Portable fundus photograph. 60° field of view:
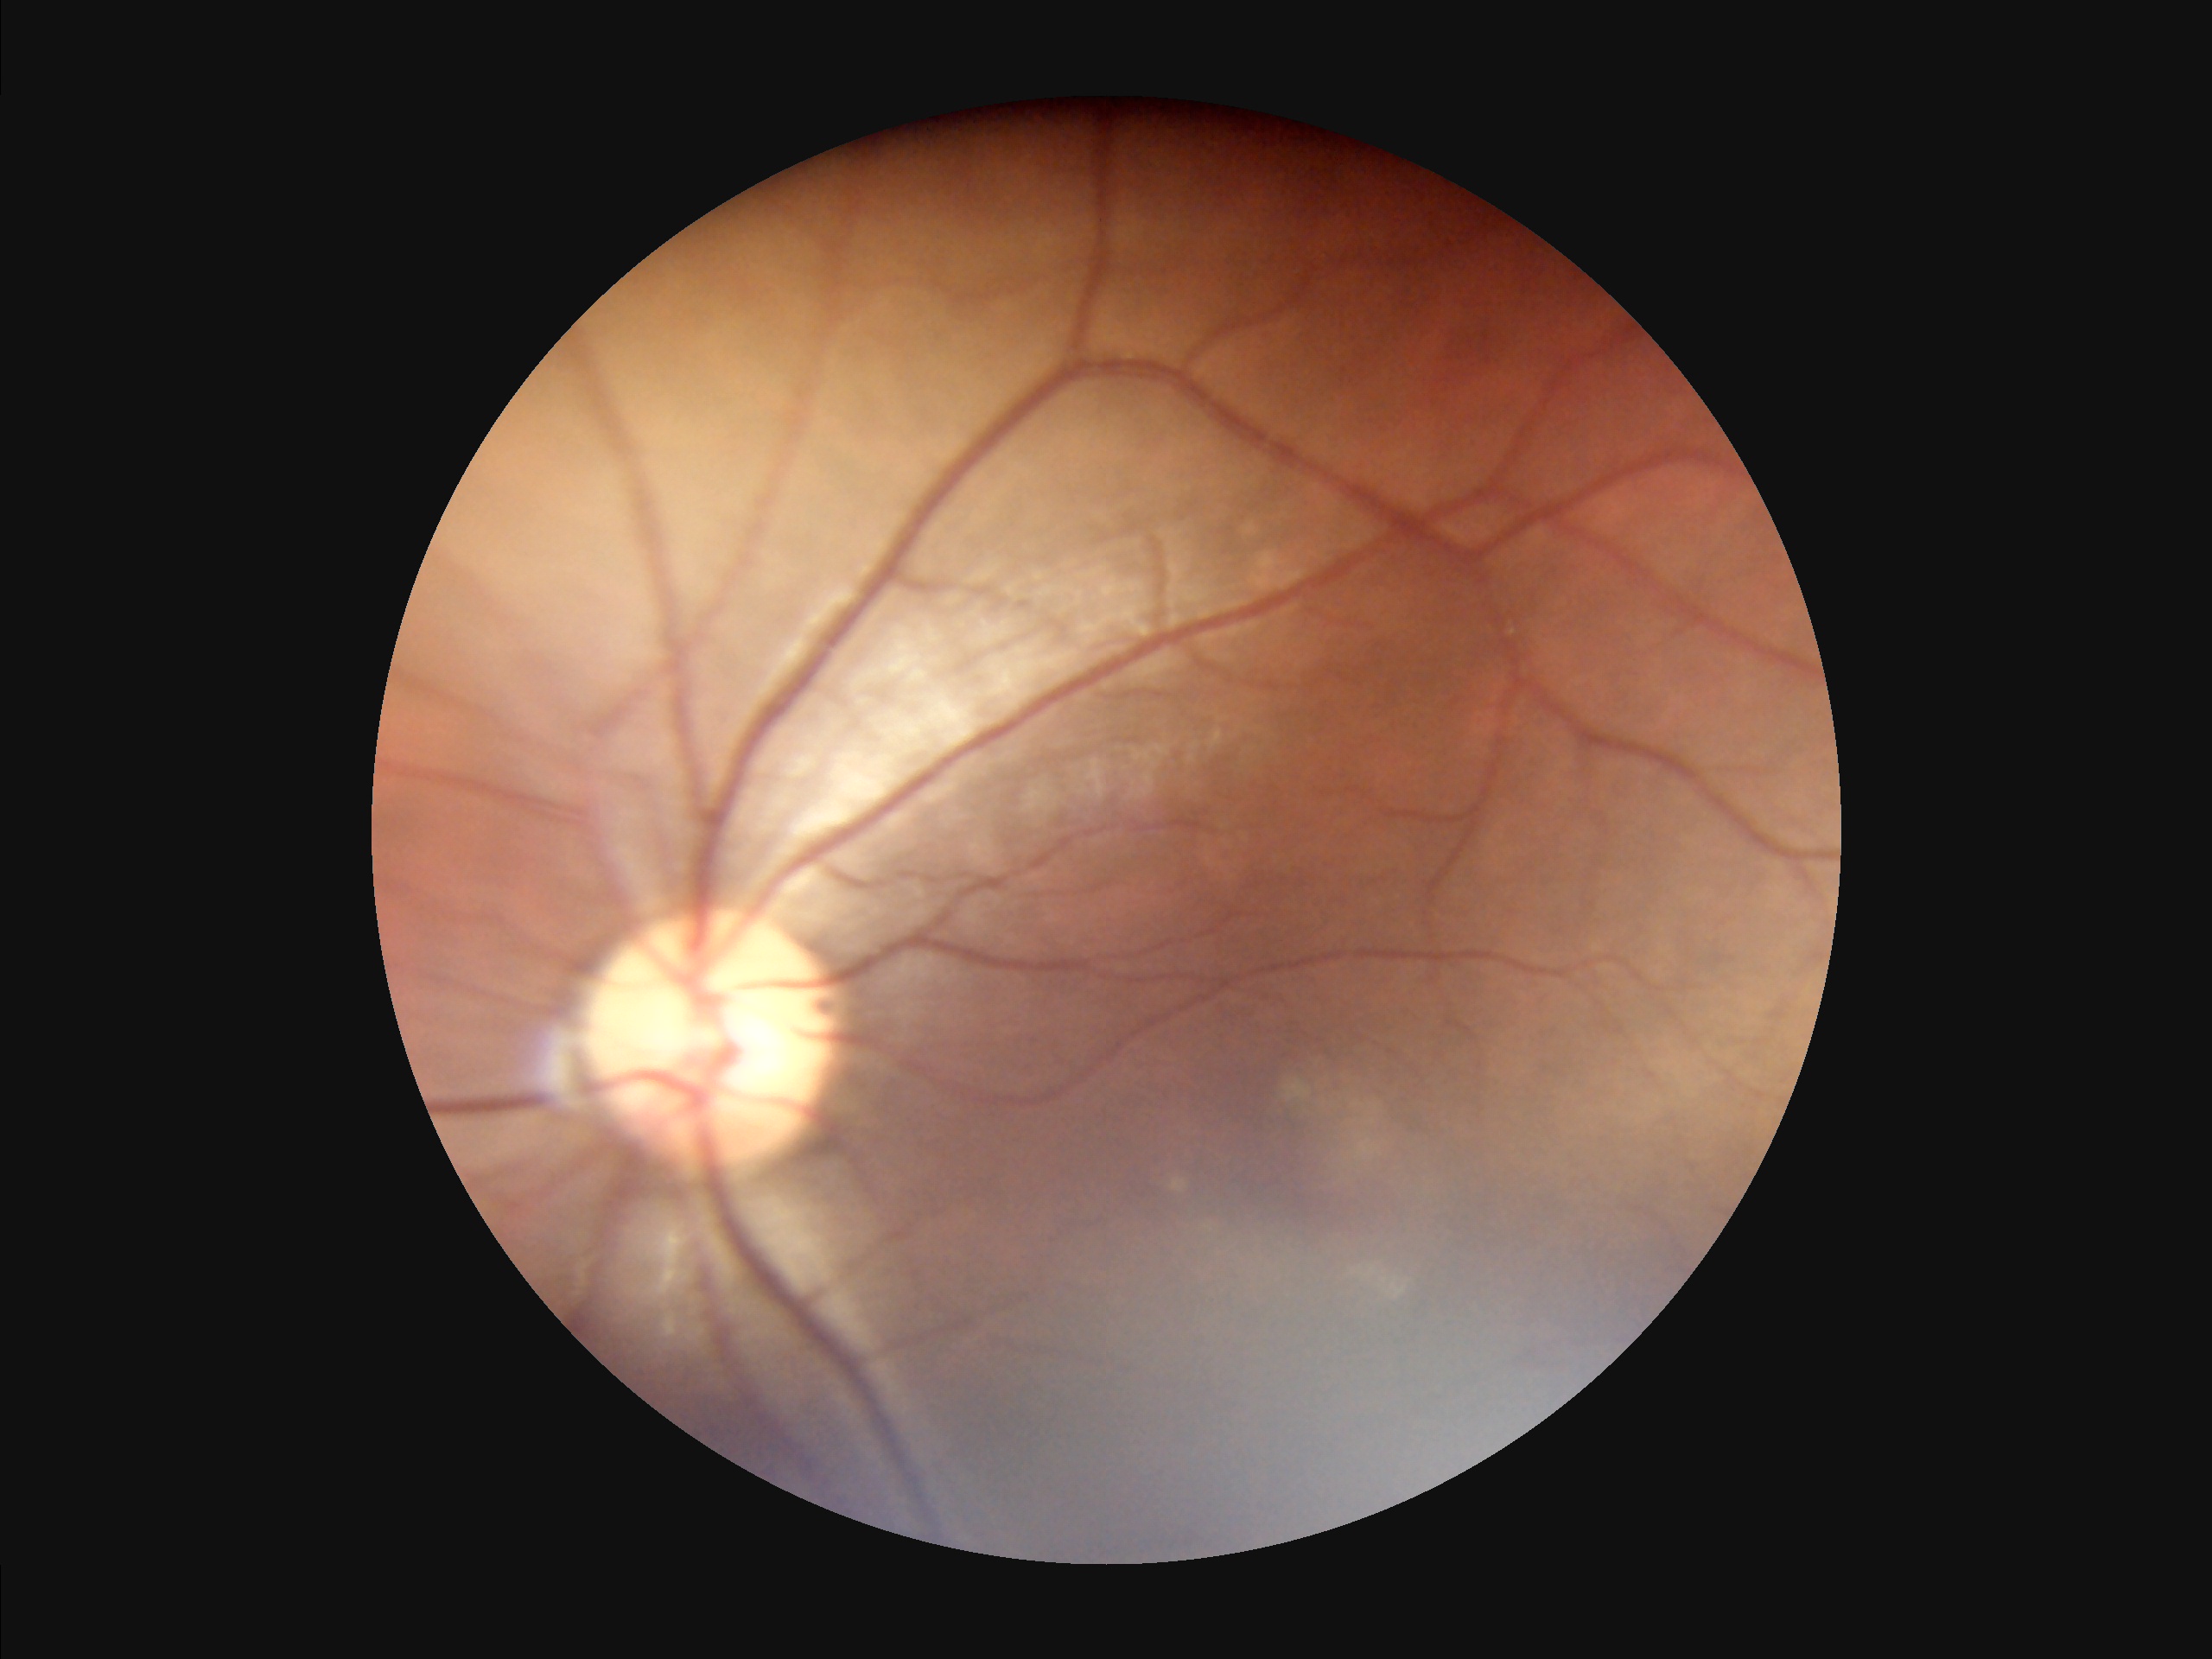
Image quality assessment: illumination/color: suboptimal | focus: in focus | overall: poor.